848x848px · 45-degree field of view: 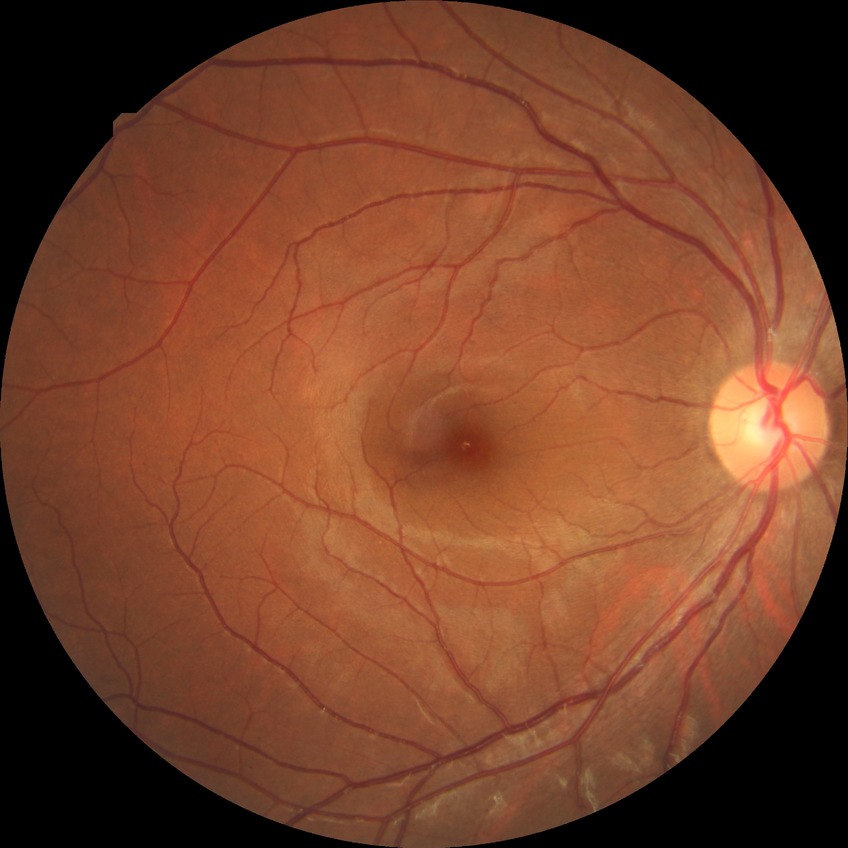
Diabetic retinopathy (DR) is NDR (no diabetic retinopathy).